45-degree field of view
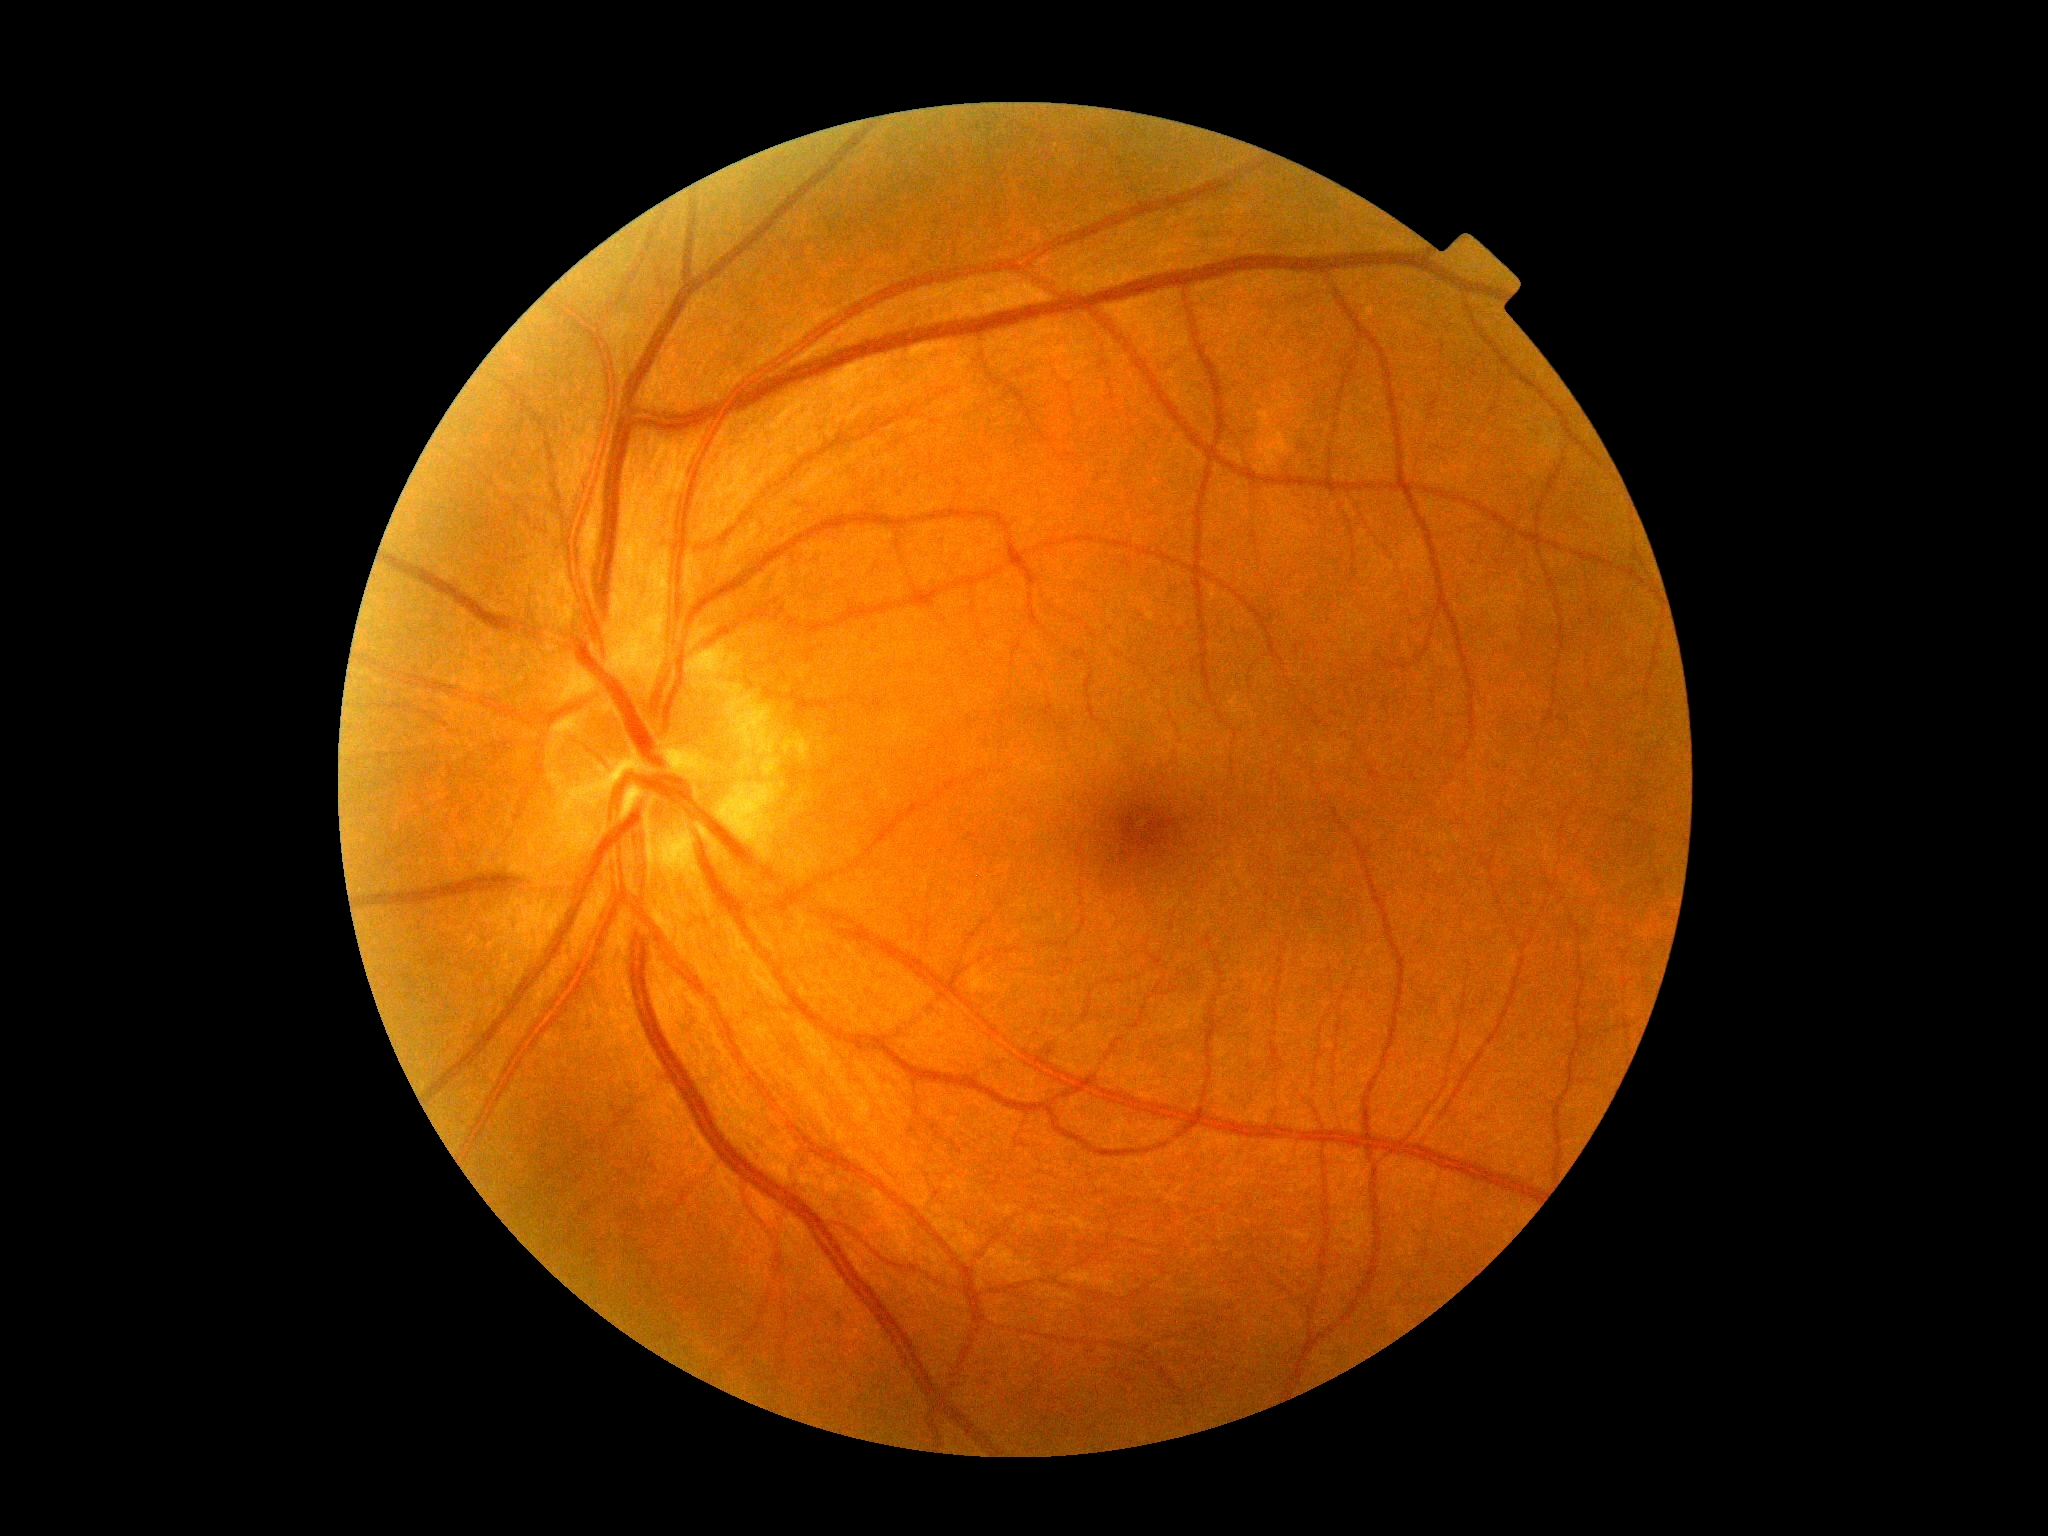 DR impression: no signs of DR
DR: no apparent retinopathy (grade 0)